Pediatric retinal photograph (wide-field):
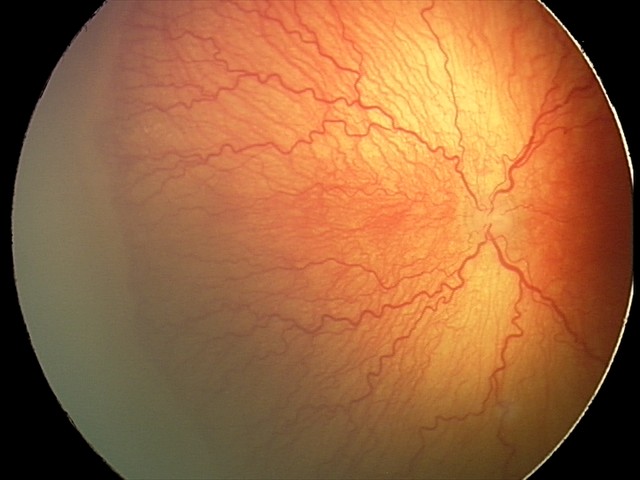
From an examination with diagnosis of A-ROP (aggressive ROP).